FOV: 45 degrees.
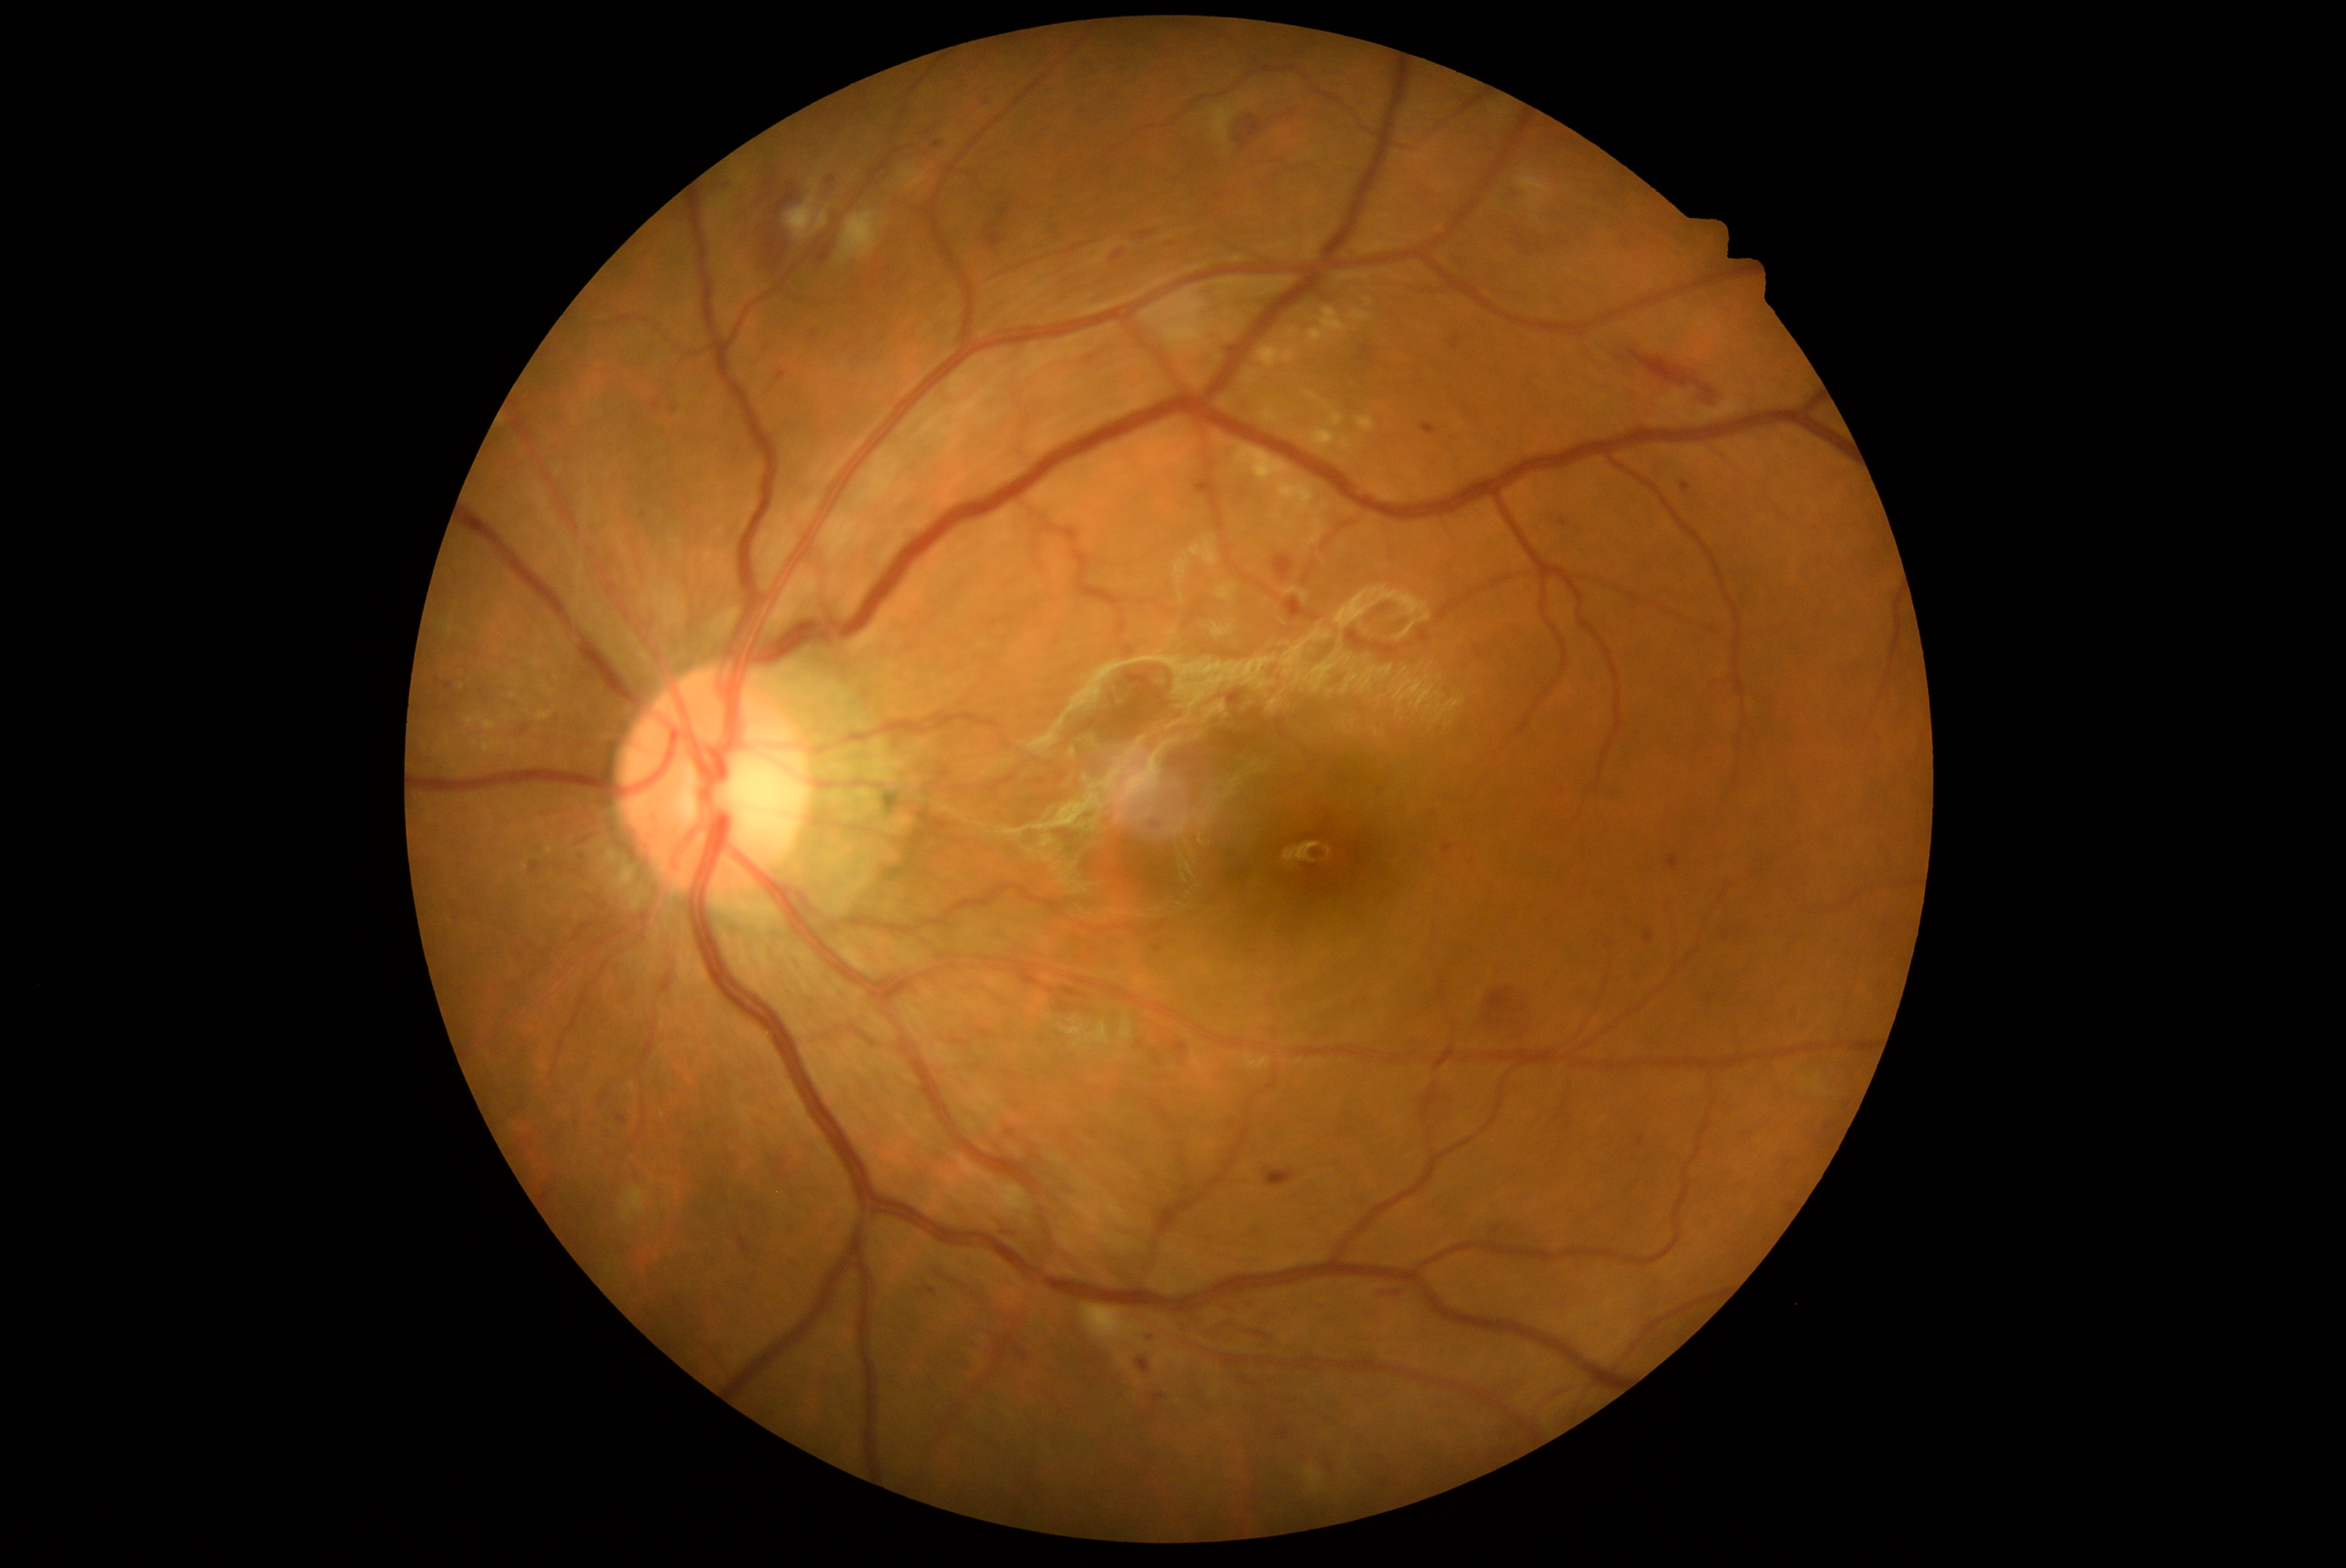

DR stage: grade 2
Lesions identified (partial list):
* MAs (continued): bbox=(1560, 517, 1569, 529); bbox=(1666, 857, 1680, 869); bbox=(1174, 1044, 1188, 1054); bbox=(1420, 423, 1439, 435); bbox=(641, 512, 647, 520); bbox=(1444, 846, 1451, 854); bbox=(812, 333, 816, 341); bbox=(928, 1288, 935, 1296); bbox=(775, 372, 786, 383); bbox=(652, 402, 659, 410); bbox=(1638, 1138, 1644, 1147); bbox=(1680, 481, 1691, 493); bbox=(1644, 932, 1654, 943); bbox=(1058, 772, 1066, 783)
* MAs (small, approximate centers) near <pt>607,1098</pt>; <pt>1828,1130</pt>; <pt>573,872</pt>
* HEs (continued): bbox=(1138, 1360, 1150, 1371); bbox=(1516, 233, 1530, 256); bbox=(1511, 181, 1528, 192); bbox=(1255, 1332, 1271, 1340); bbox=(995, 1337, 1028, 1362); bbox=(1538, 244, 1544, 252); bbox=(818, 247, 832, 264); bbox=(1702, 387, 1716, 399); bbox=(764, 236, 786, 269); bbox=(982, 222, 1004, 250); bbox=(774, 191, 796, 216)
* HEs (small, approximate centers) near <pt>1621,359</pt>